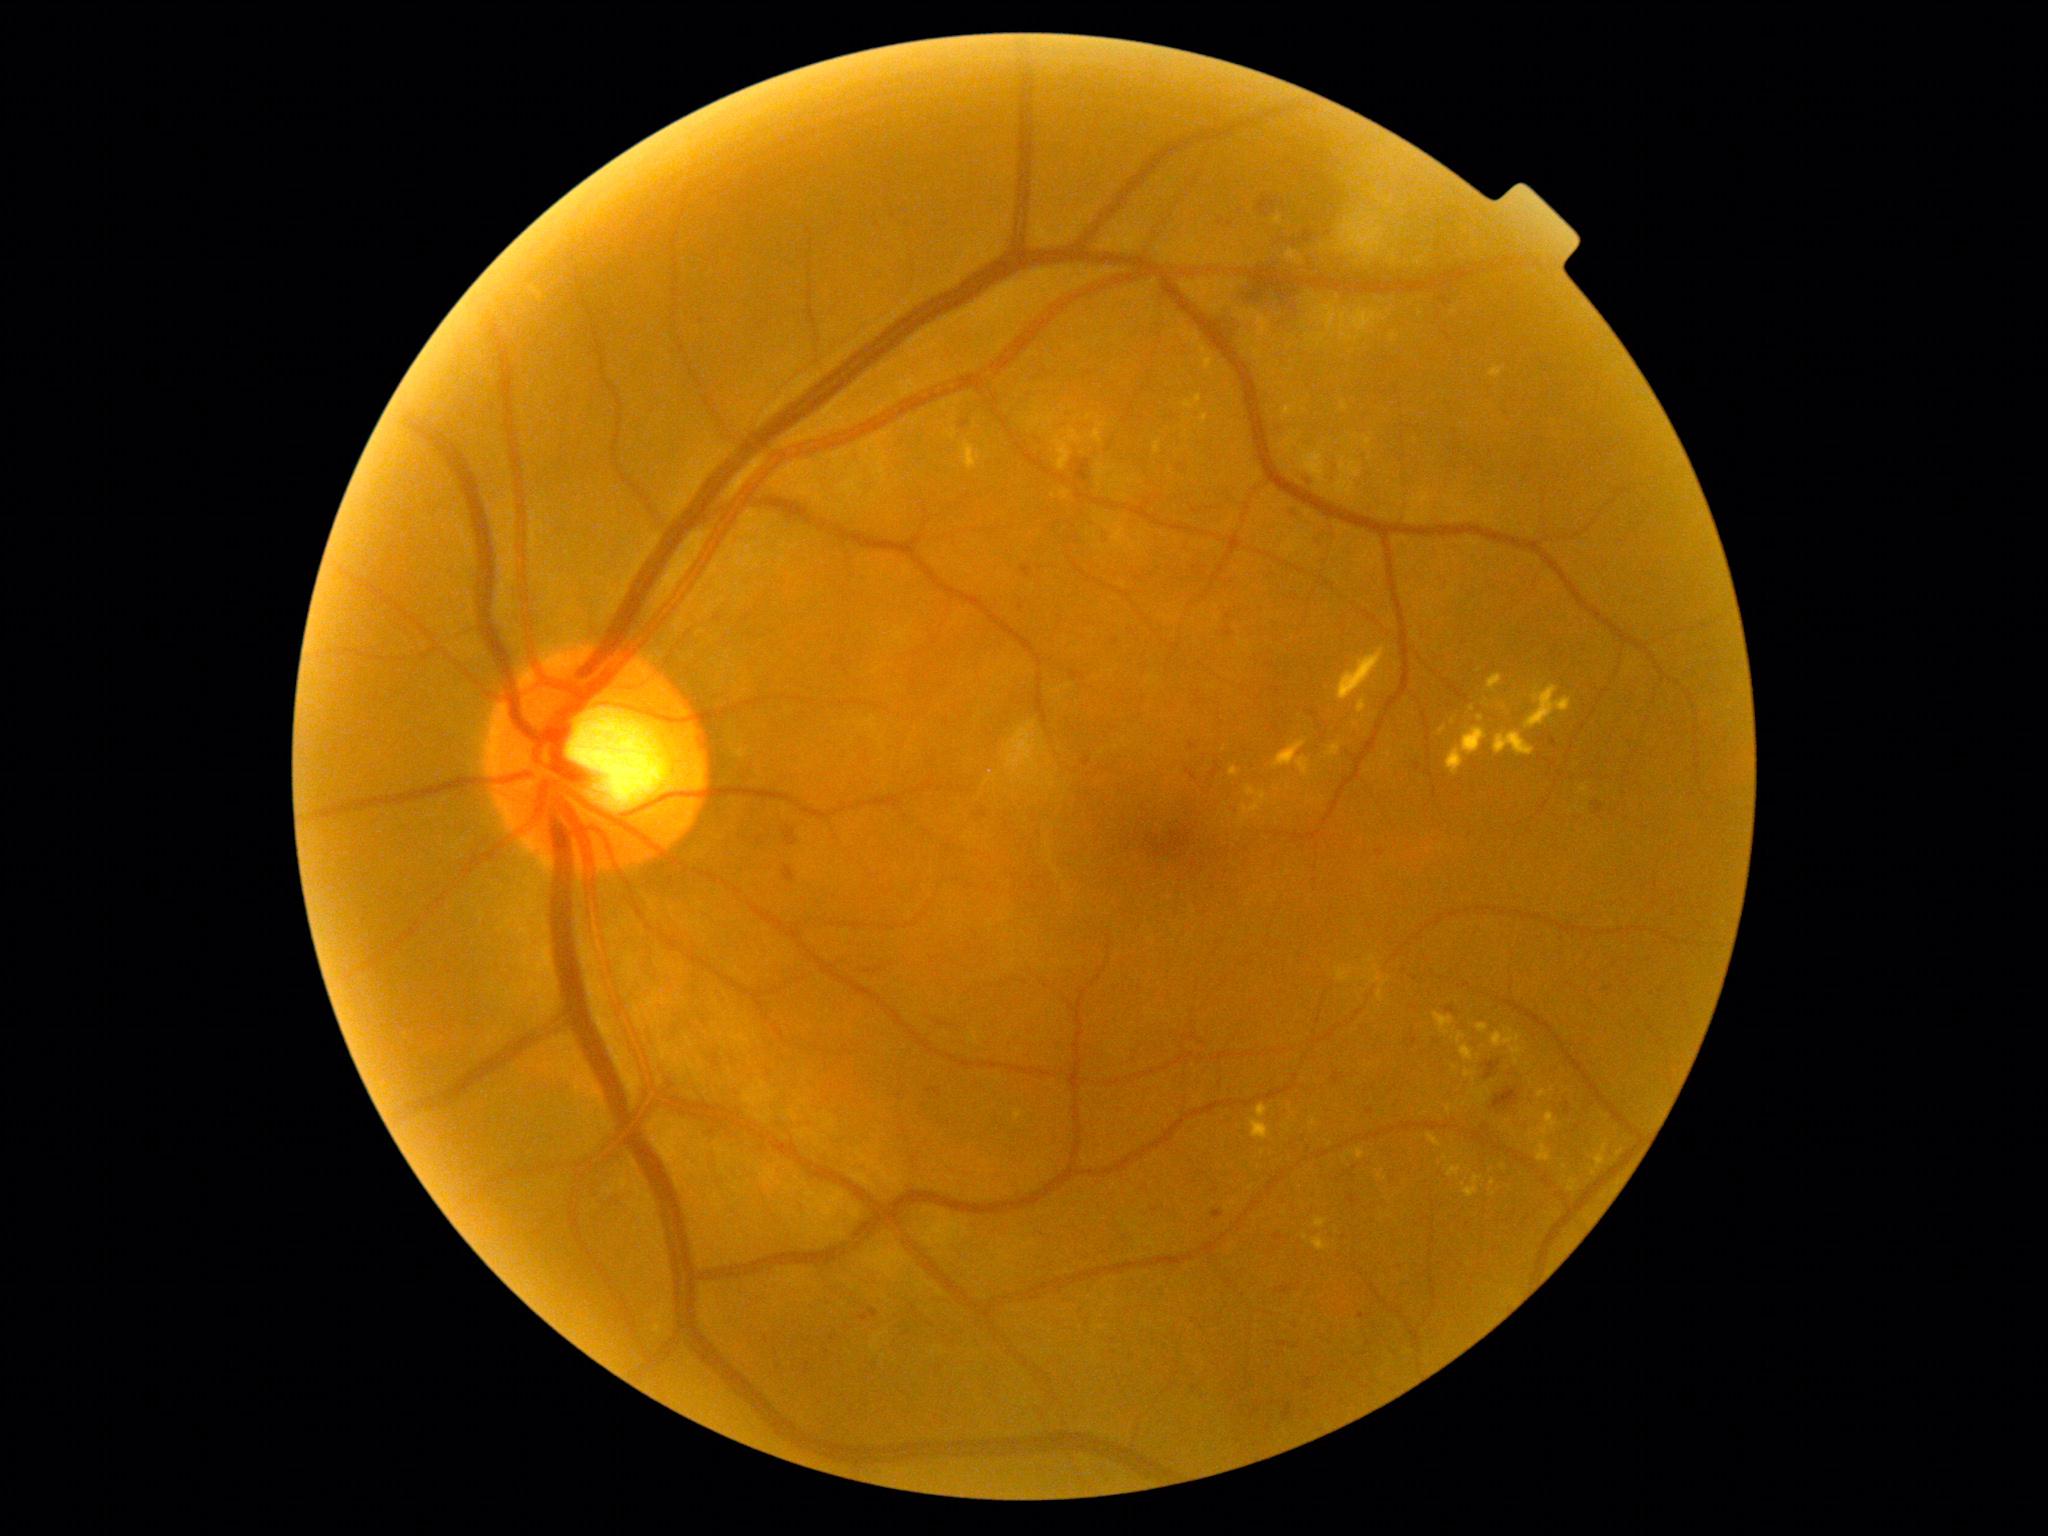 Diabetic retinopathy is moderate NPDR (grade 2) — more than just microaneurysms but less than severe NPDR
Representative lesions:
hard exudates (continued) = <box>1433,1012,1455,1035</box>; <box>1241,785,1270,816</box>; <box>1456,1032,1466,1045</box>; <box>1188,329,1198,345</box>; <box>1472,1090,1488,1105</box>; <box>1286,249,1304,265</box>; <box>1446,727,1488,773</box>; <box>1428,1134,1442,1147</box>; <box>1342,401,1349,411</box>; <box>1282,407,1294,417</box>; <box>1378,1171,1388,1181</box>
Smaller hard exudates around point(1502, 1129); point(1605, 1116); point(1531, 1134); point(1446, 1157); point(1465, 1104)